Color fundus image.
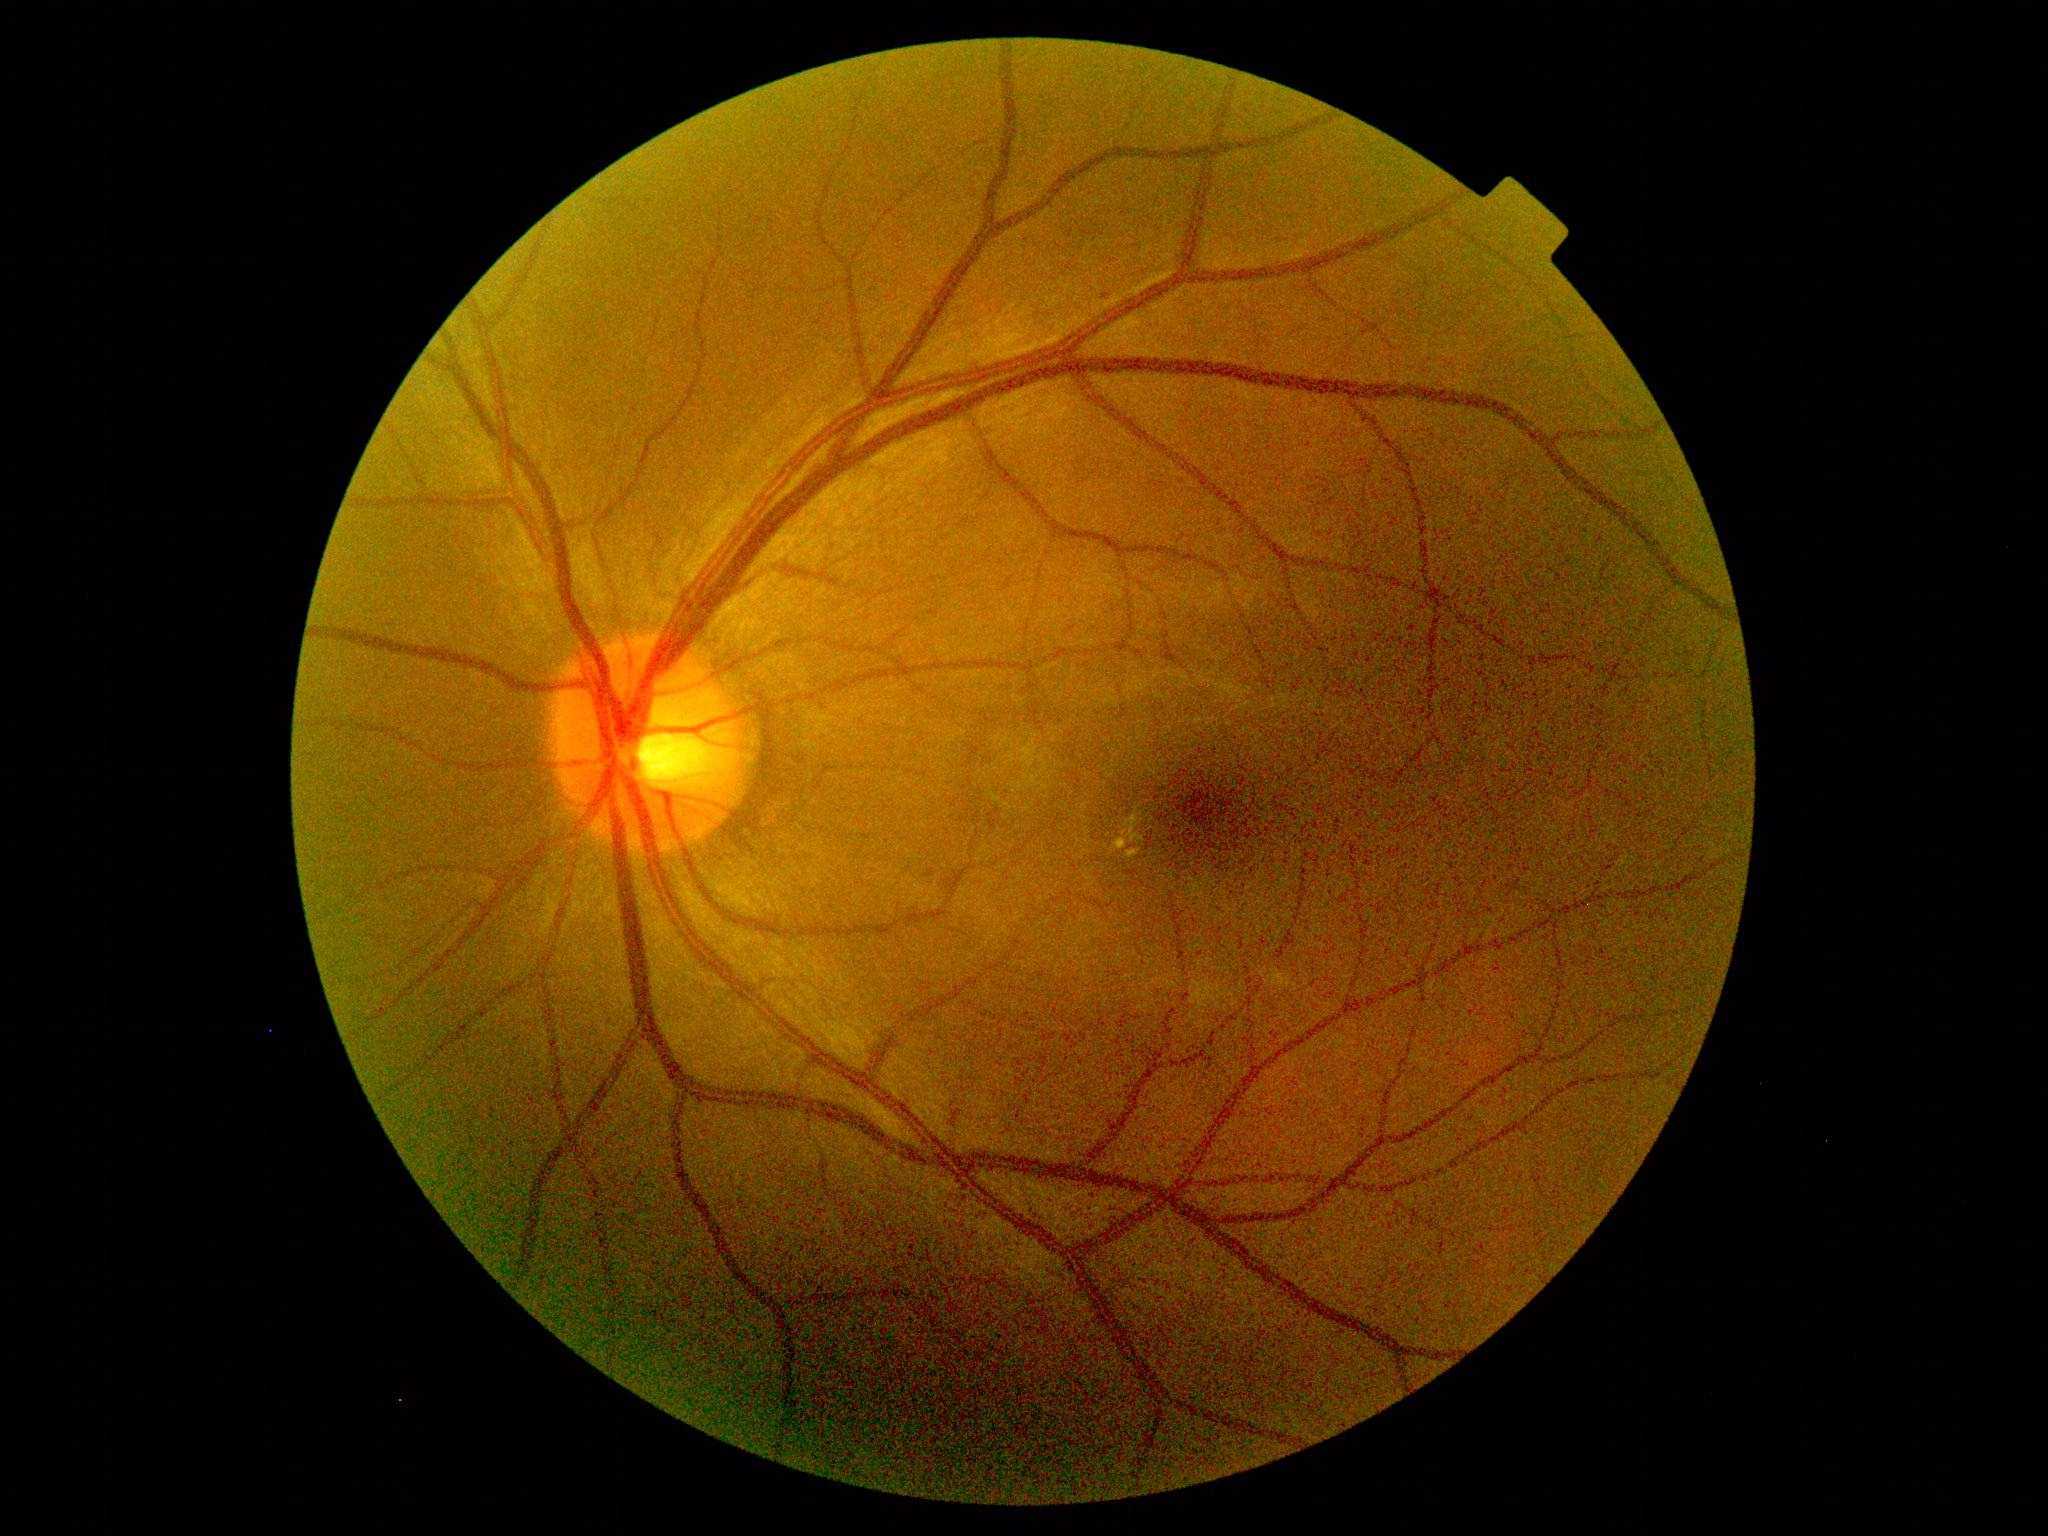

diabetic retinopathy (DR) = moderate non-proliferative diabetic retinopathy (grade 2) — more than just microaneurysms but less than severe NPDR.